Image size 2352x1568. Retinal fundus photograph: 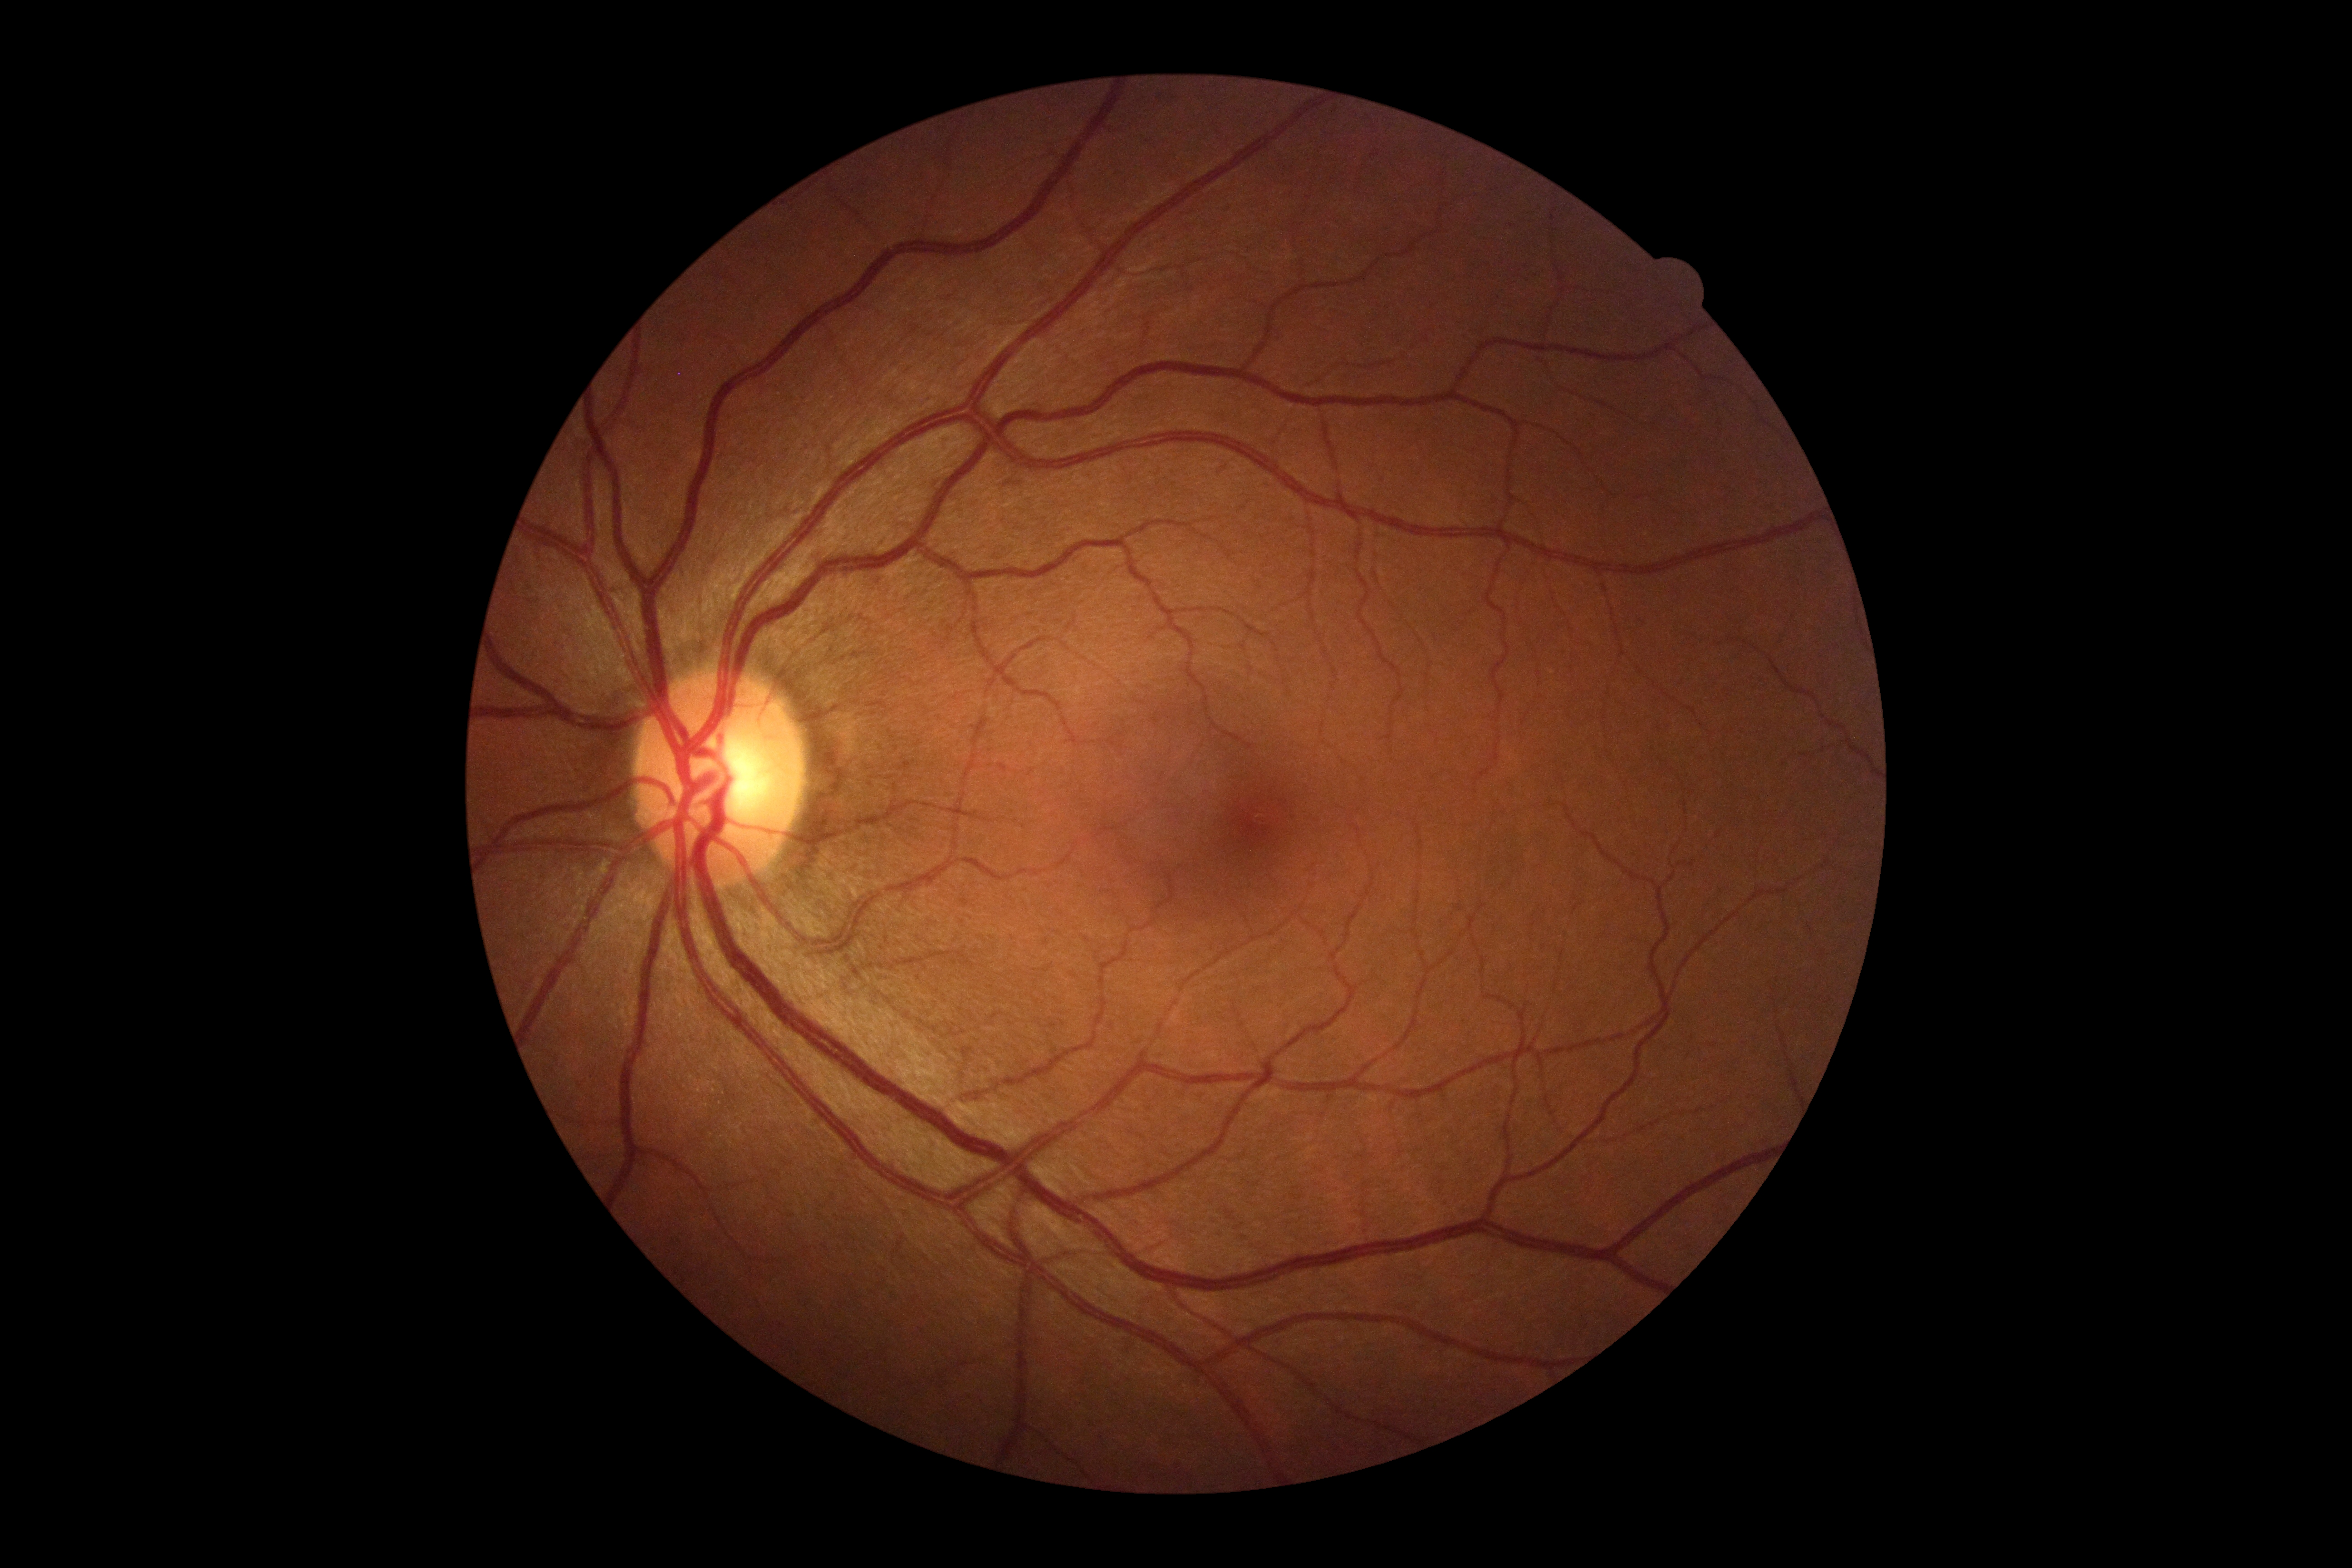

No diabetic retinal disease findings. Diabetic retinopathy (DR) is grade 0 (no apparent retinopathy).